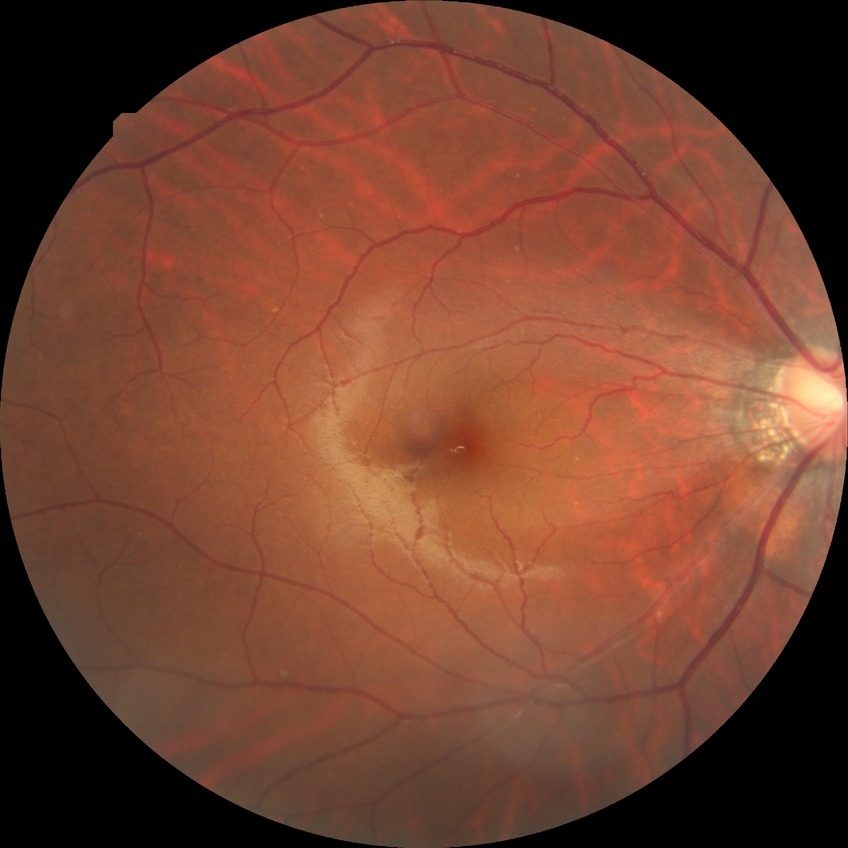

Diabetic retinopathy (DR) is simple diabetic retinopathy (SDR).